100° field of view (Phoenix ICON); infant wide-field fundus photograph; 1240x1240:
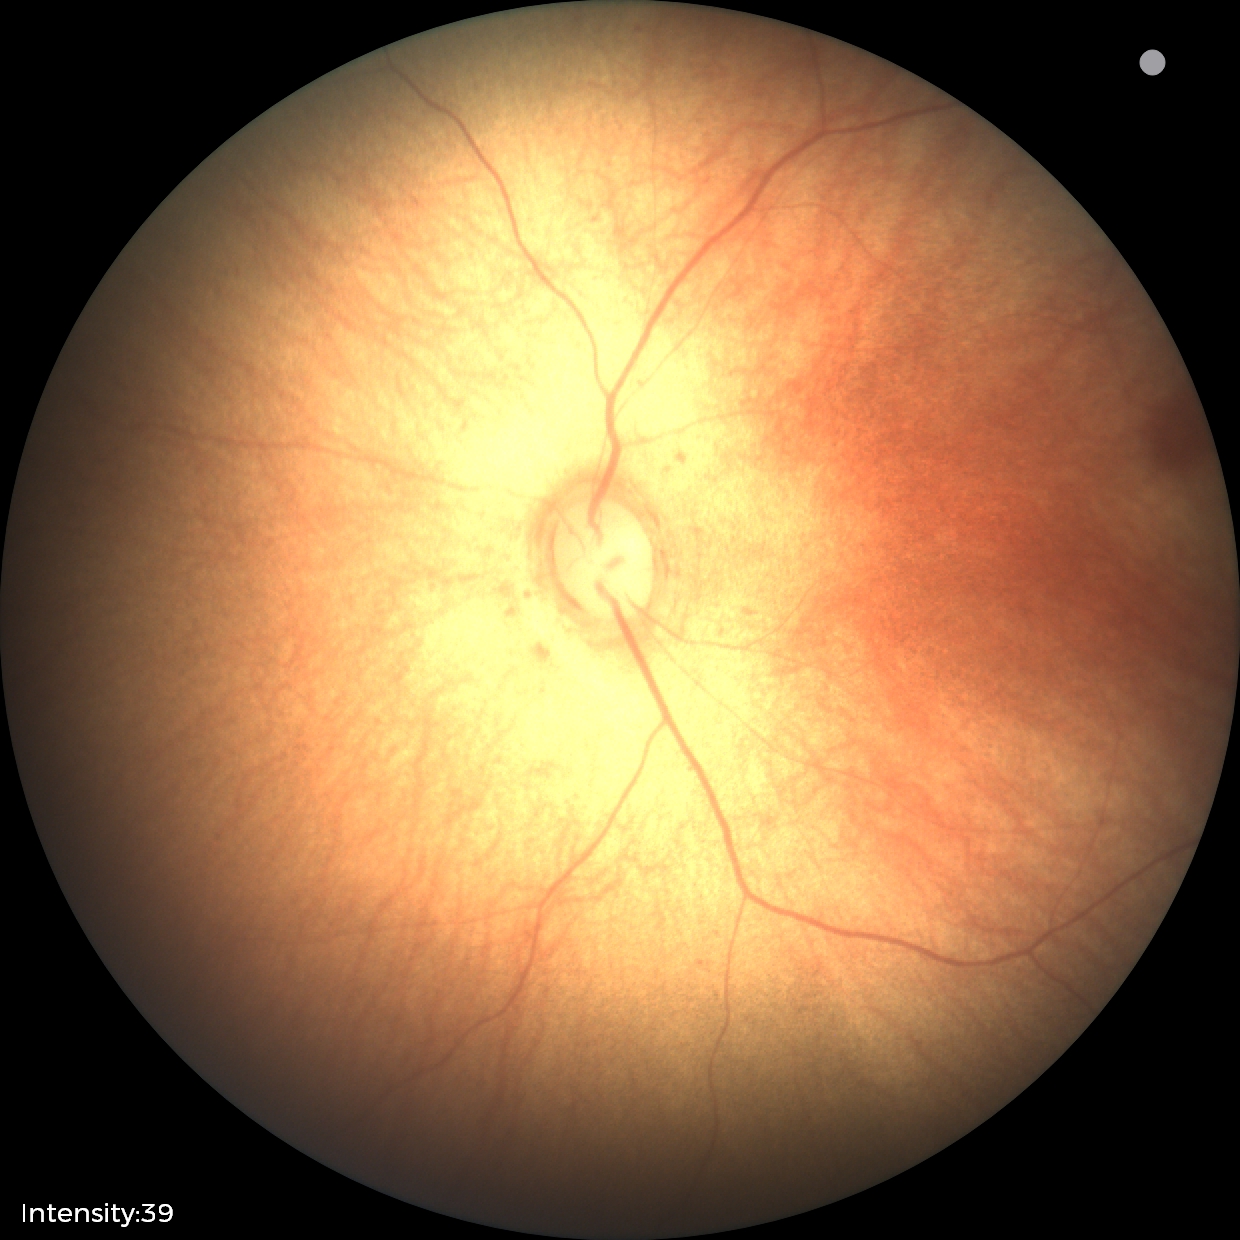
Physiological retinal appearance for postconceptual age.